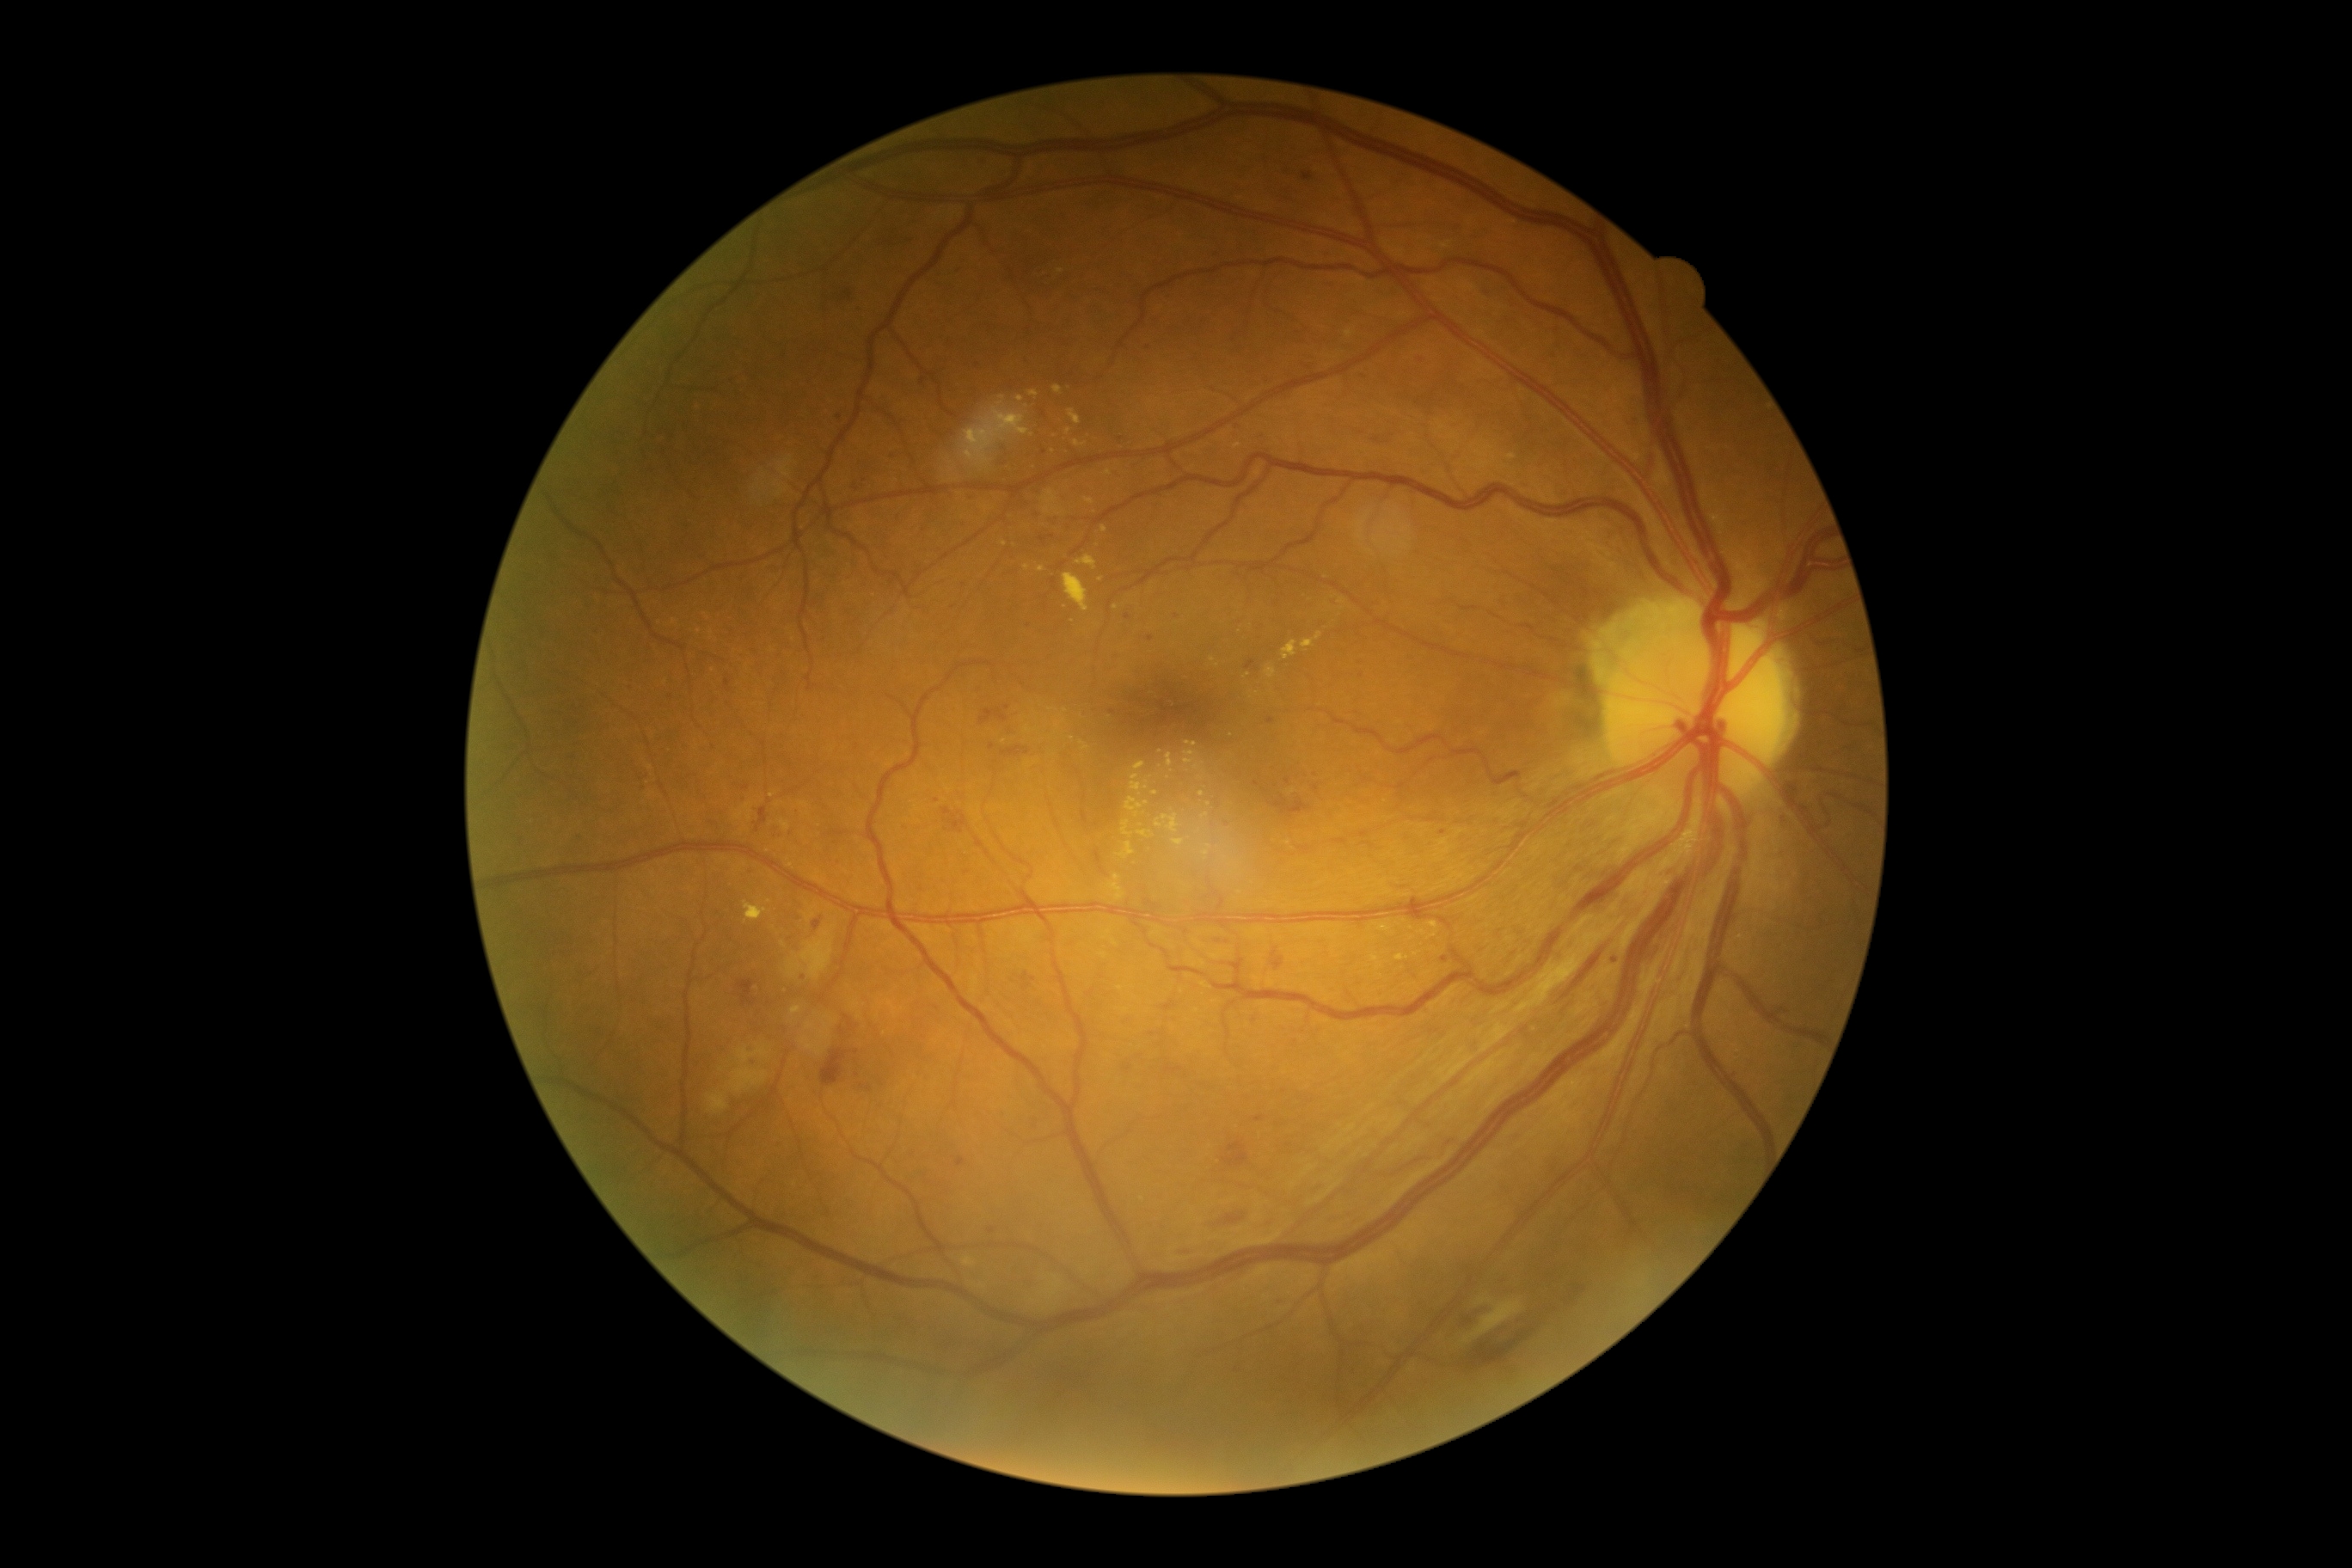
Disease class: non-proliferative diabetic retinopathy. DR severity is moderate non-proliferative diabetic retinopathy (grade 2) — more than just microaneurysms but less than severe NPDR.